Retinal fundus photograph. Image size 848x848. FOV: 45 degrees — 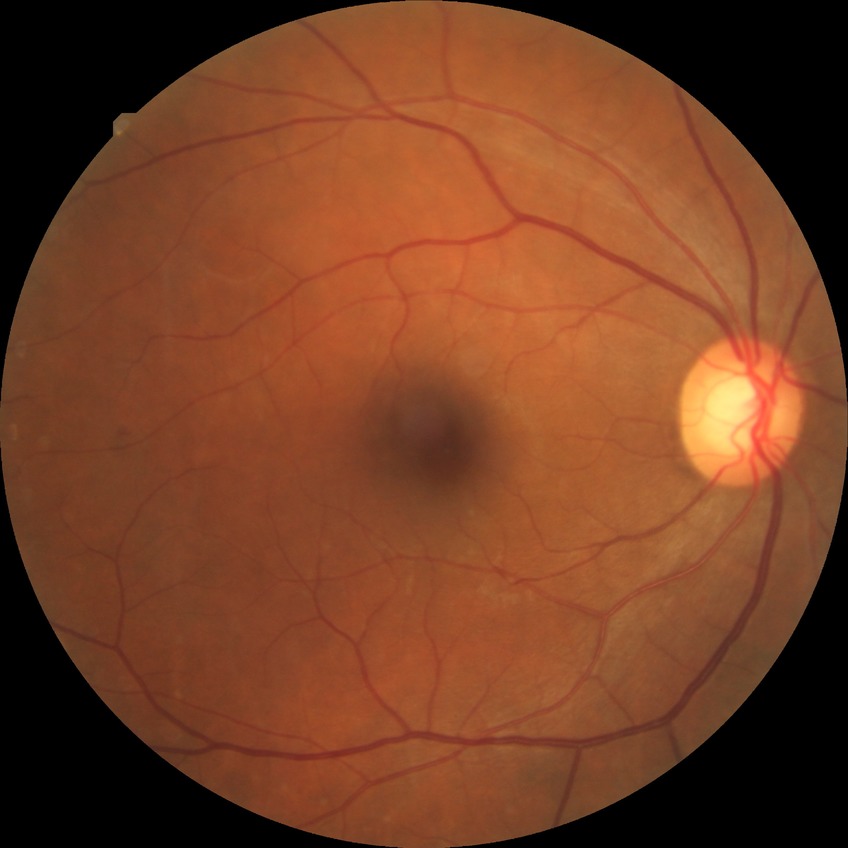

Diabetic retinopathy (DR): simple diabetic retinopathy (SDR).